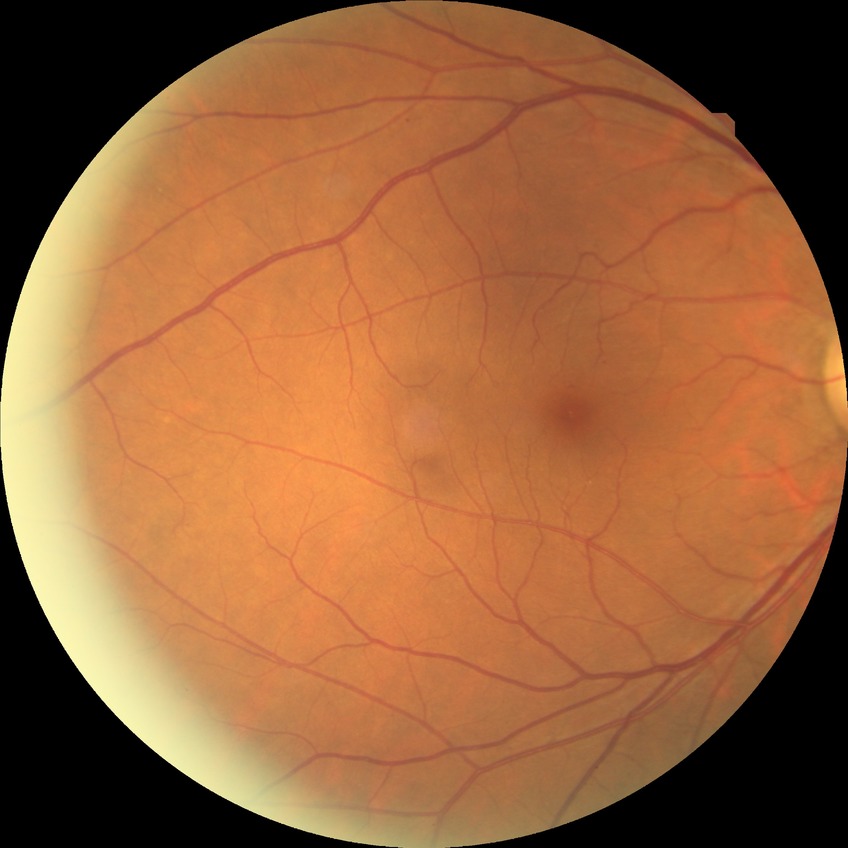 Diabetic retinopathy (DR): NDR (no diabetic retinopathy).